Modified Davis classification — 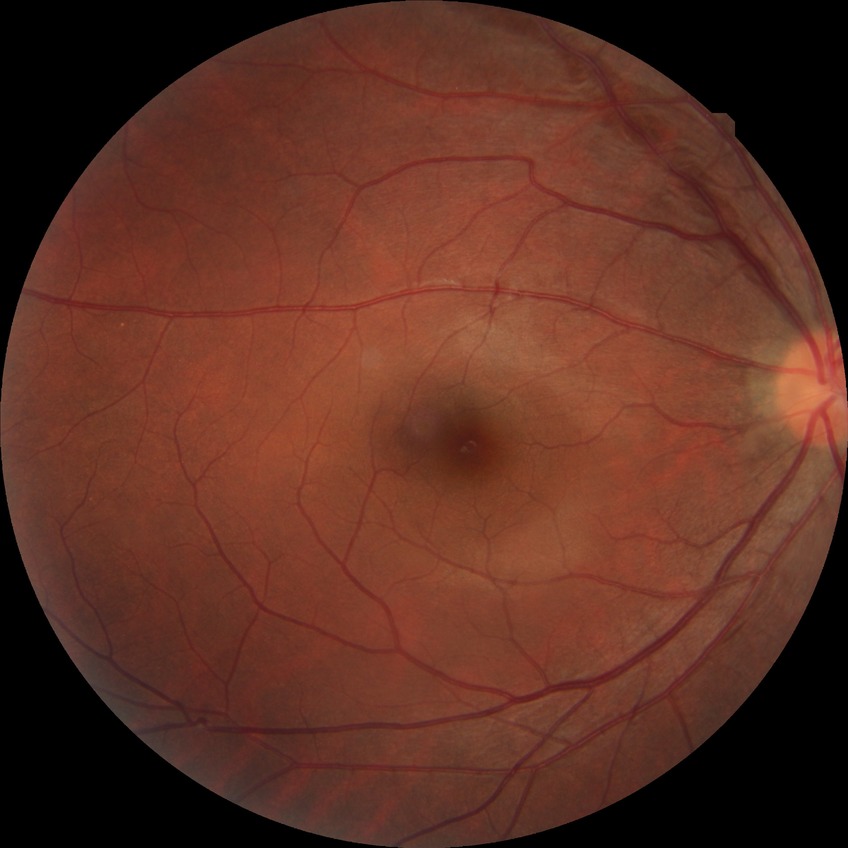

Modified Davis grading: no diabetic retinopathy.